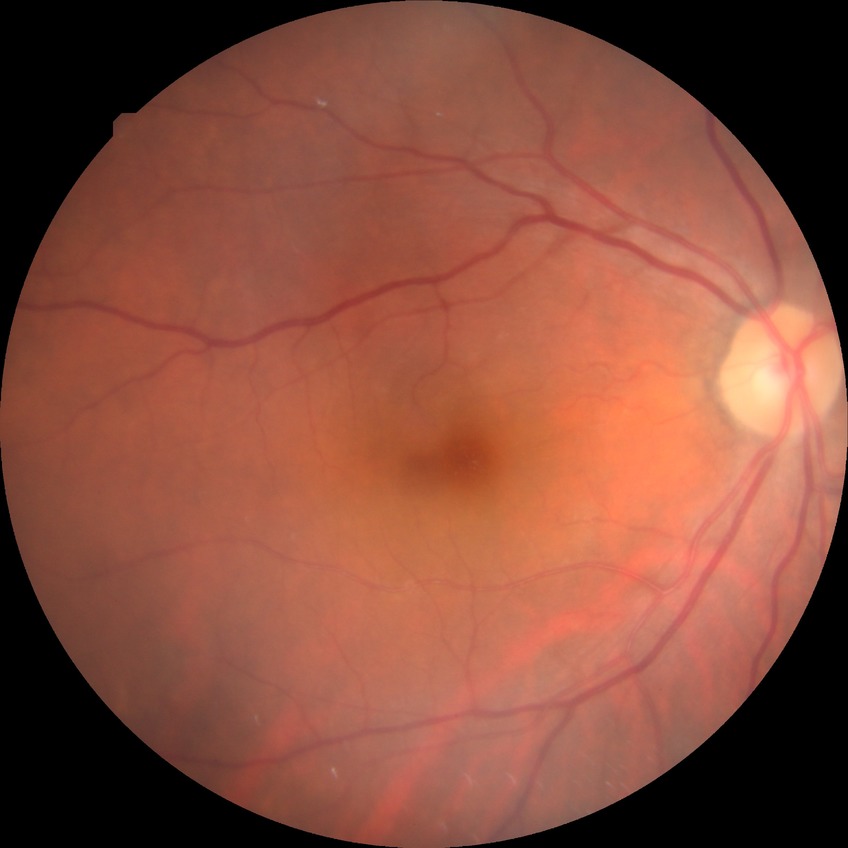 Diabetic retinopathy (DR): NDR (no diabetic retinopathy).